640x480 · wide-field fundus photograph from neonatal ROP screening · Clarity RetCam 3, 130° FOV: 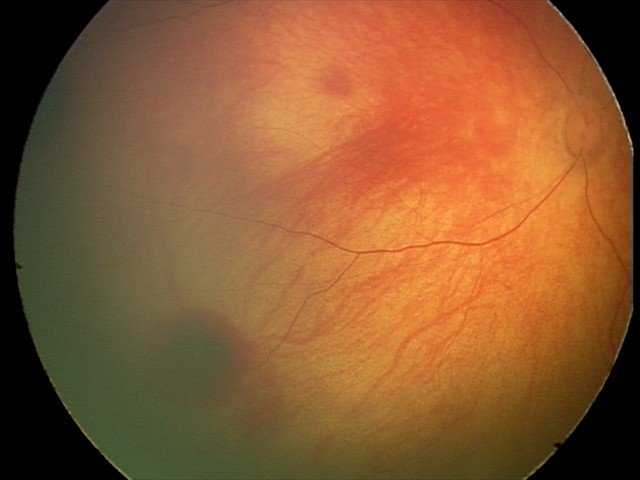 Screening series with retinal hemorrhages.